Wide-field fundus photograph of an infant. 130° field of view (Natus RetCam Envision)
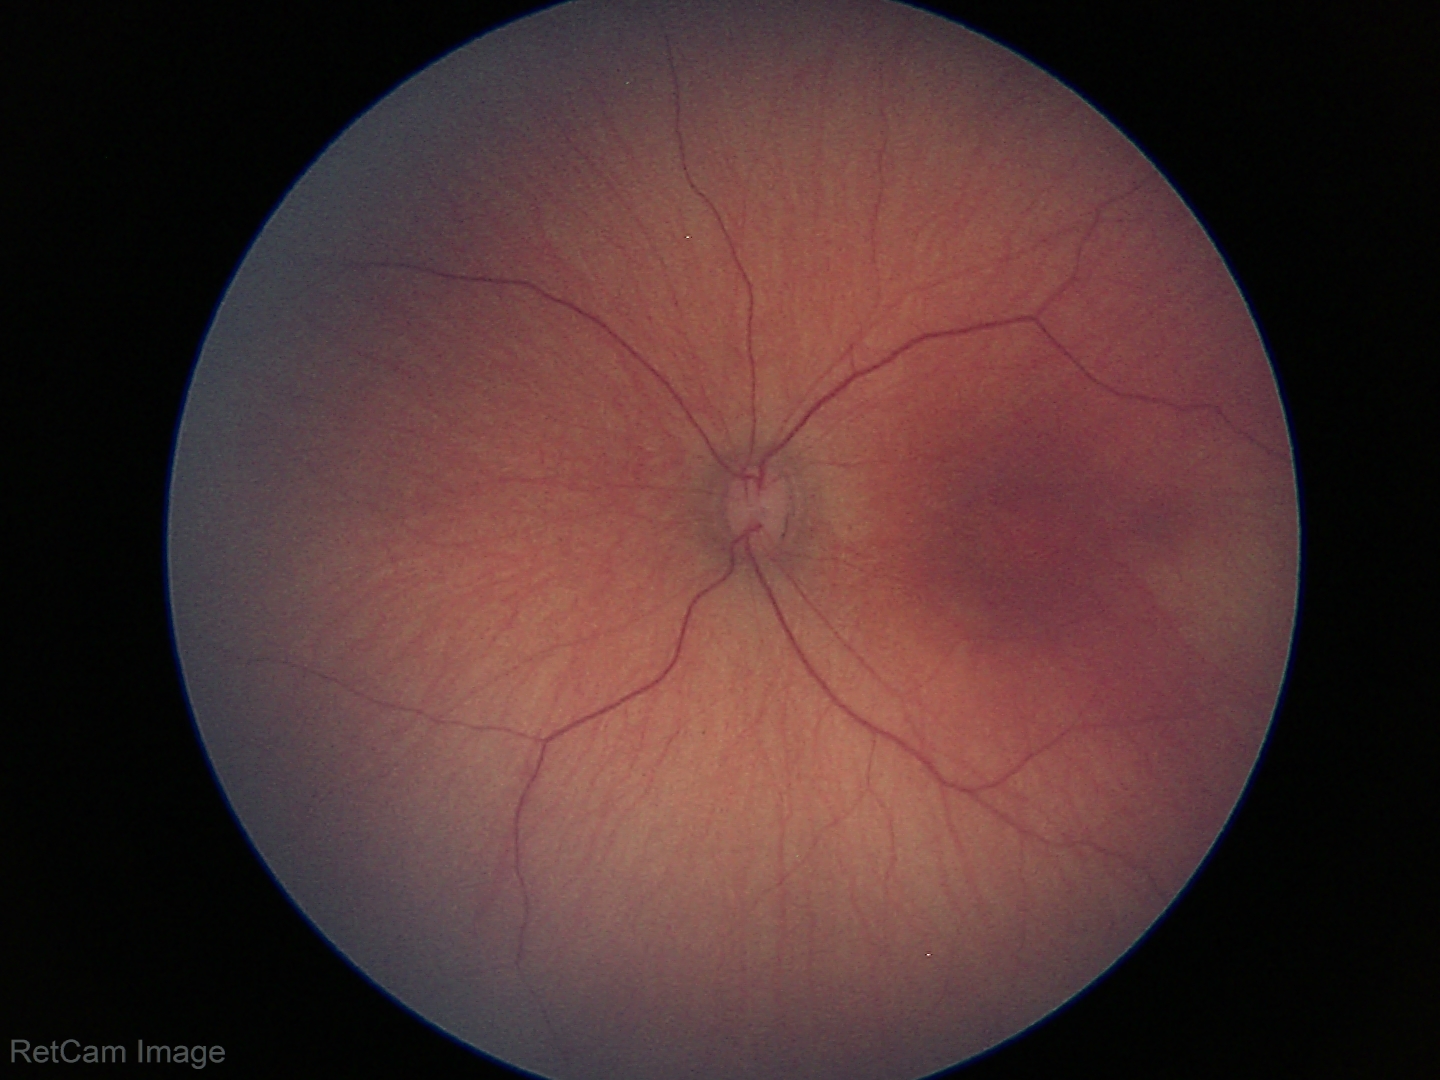
No retinal pathology identified on screening.